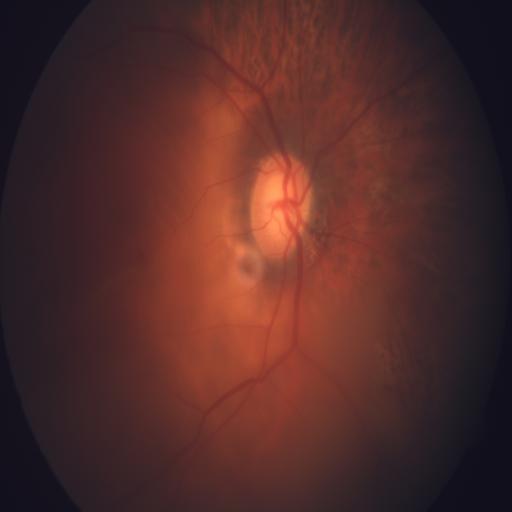

Color fundus photograph showing tessellation & tilted disc.